1536 by 1152 pixels.
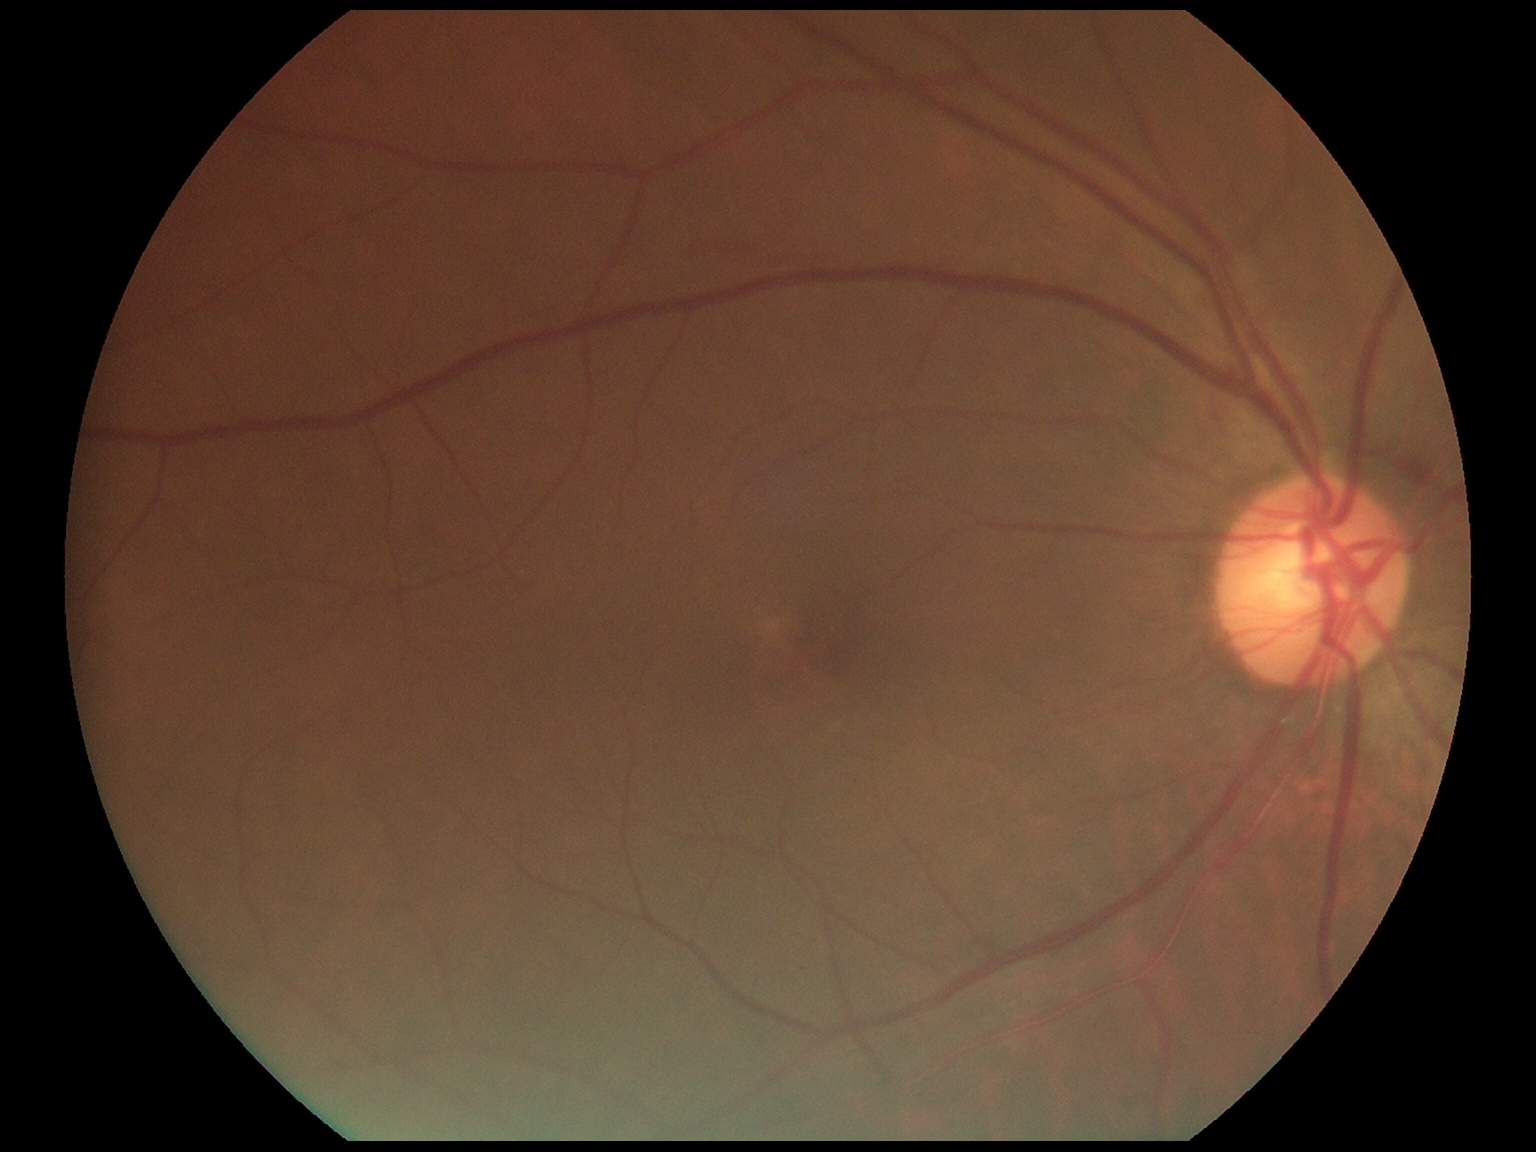

DR: grade 2 (moderate NPDR).
Disease class: non-proliferative diabetic retinopathy.